1380 by 1382 pixels
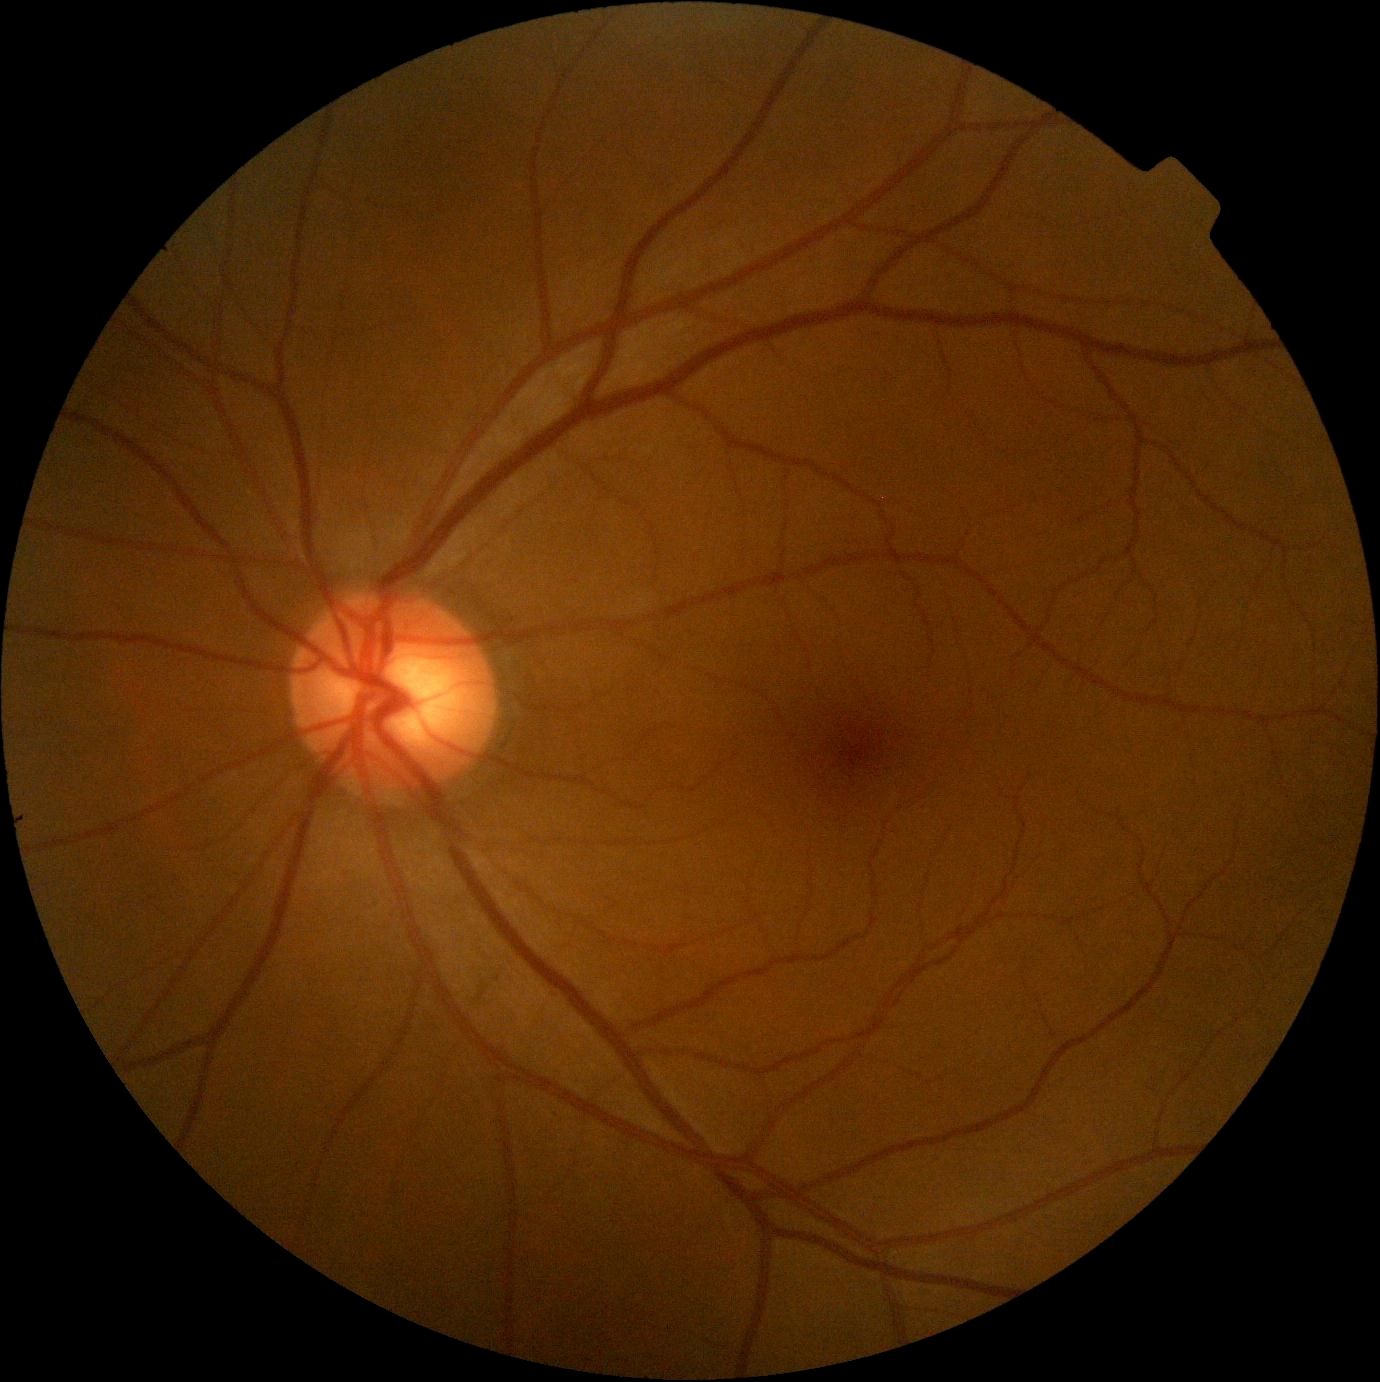 Diabetic retinopathy severity is 0.